1440 x 1080 pixels · wide-field contact fundus photograph of an infant:
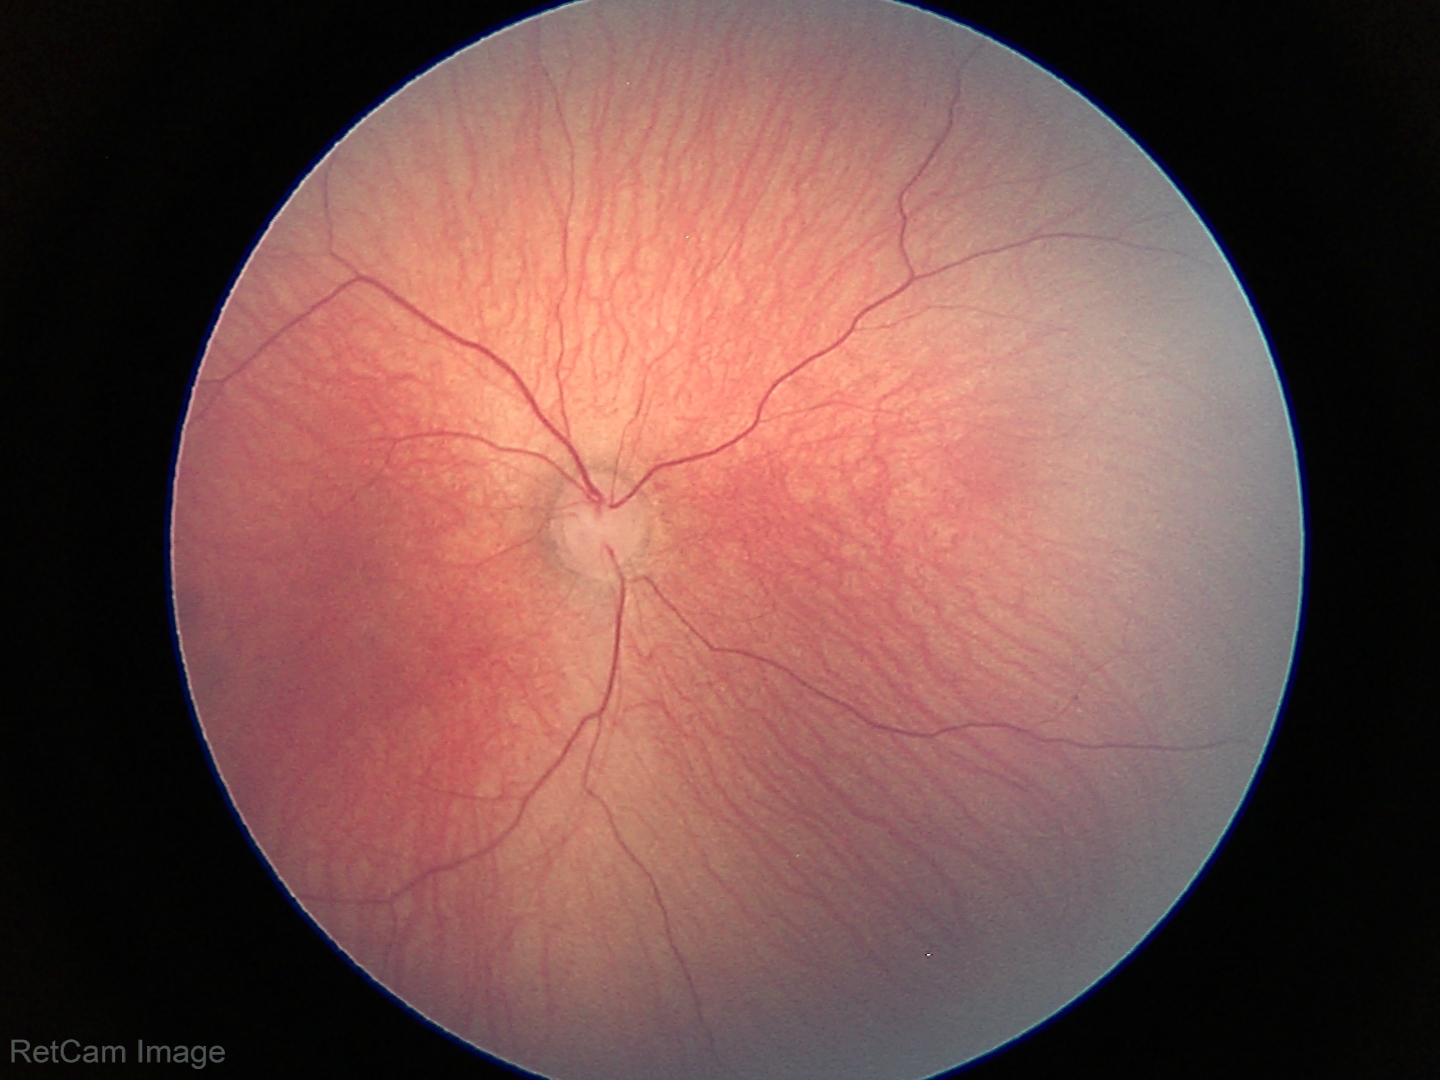

Examination with physiological retinal findings.